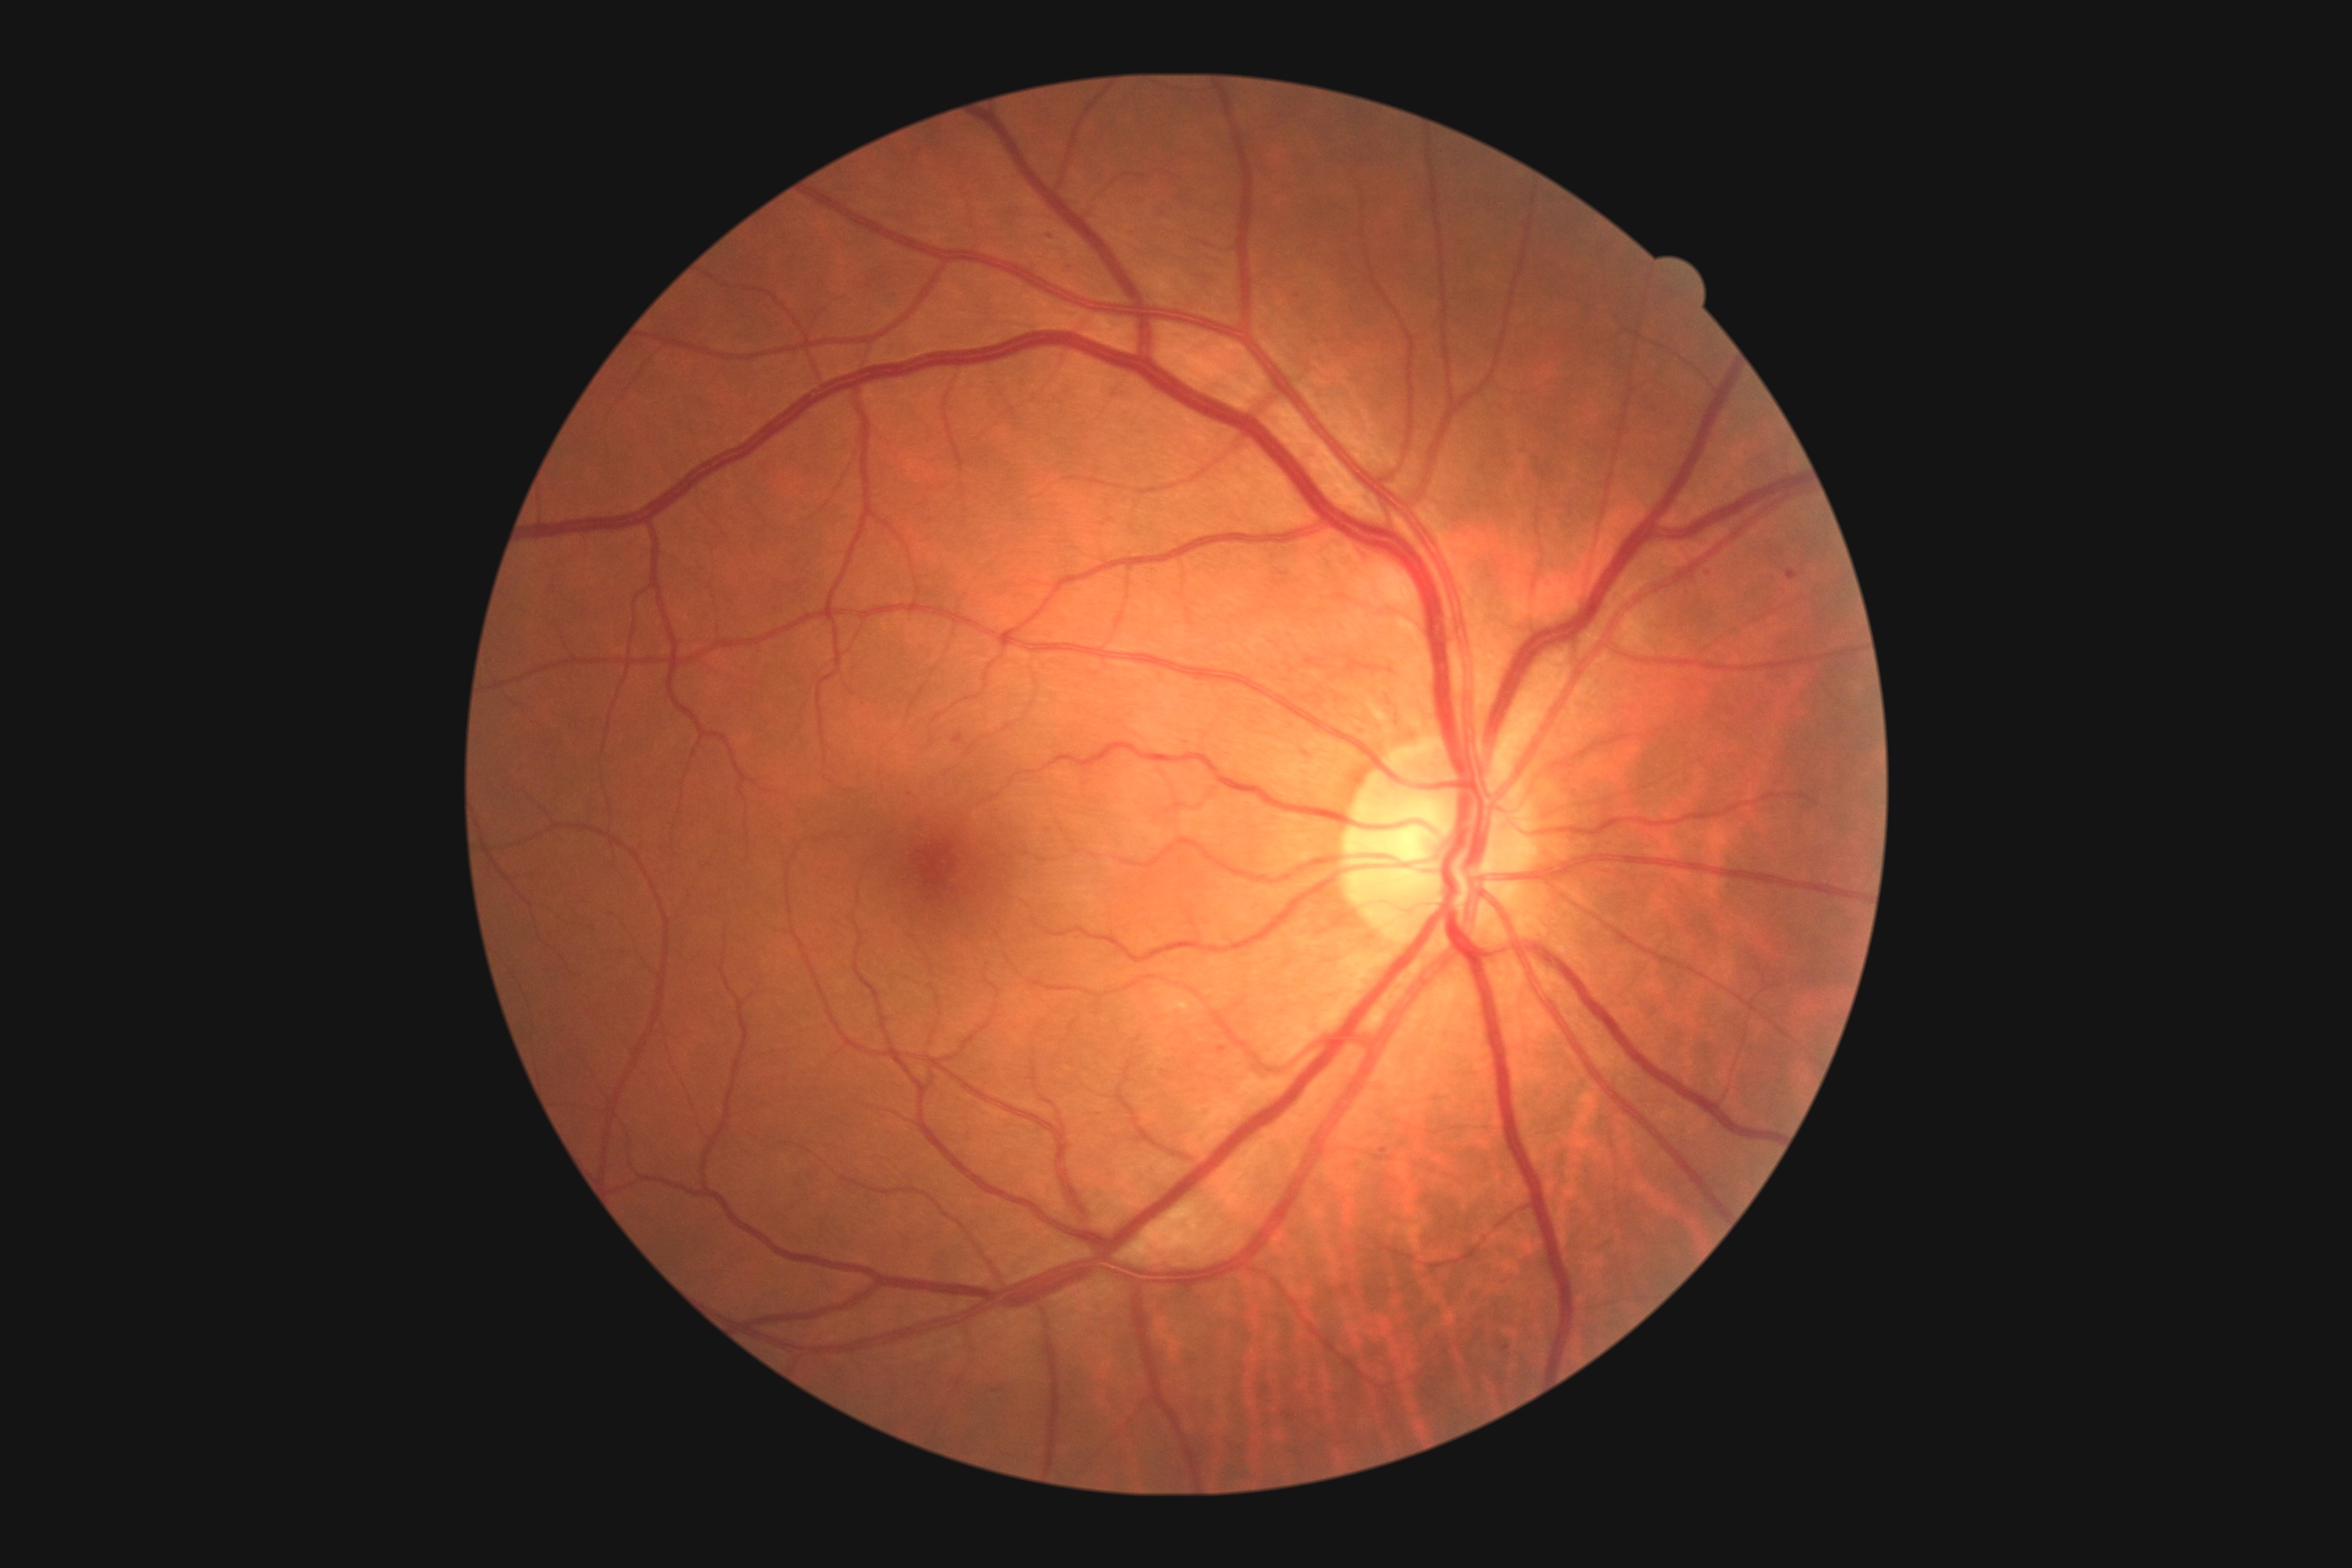
diabetic retinopathy severity: 2 — more than just microaneurysms but less than severe NPDR, DR class: non-proliferative diabetic retinopathy.